45 degree fundus photograph, fundus photo, acquired with a NIDEK AFC-230 — 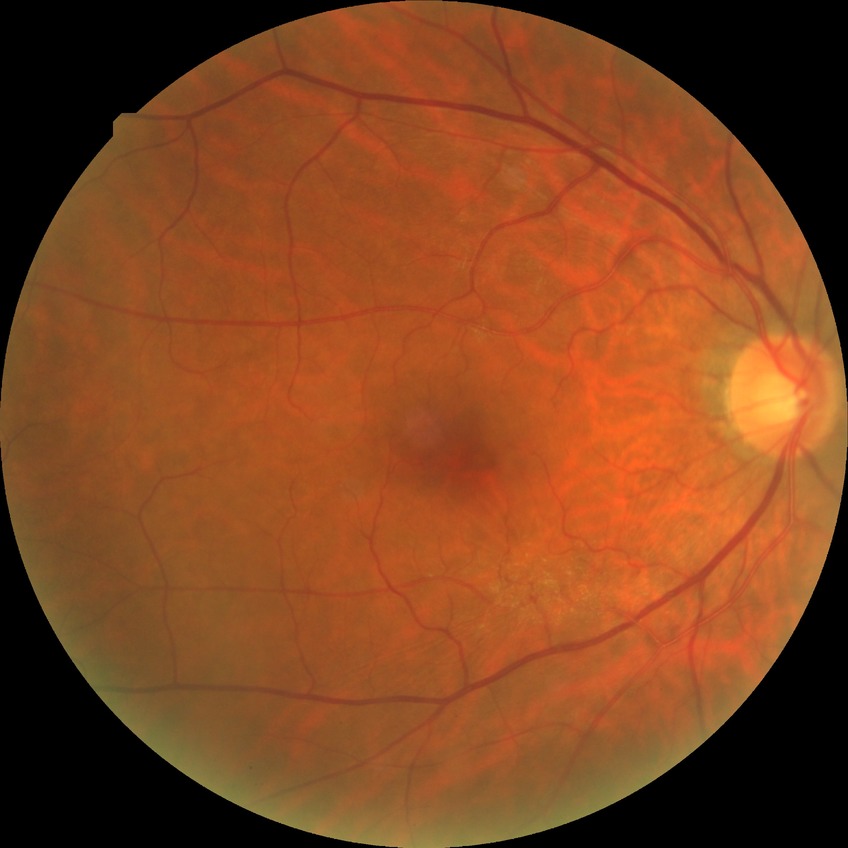
{
  "davis_grade": "NDR (no diabetic retinopathy)"
}